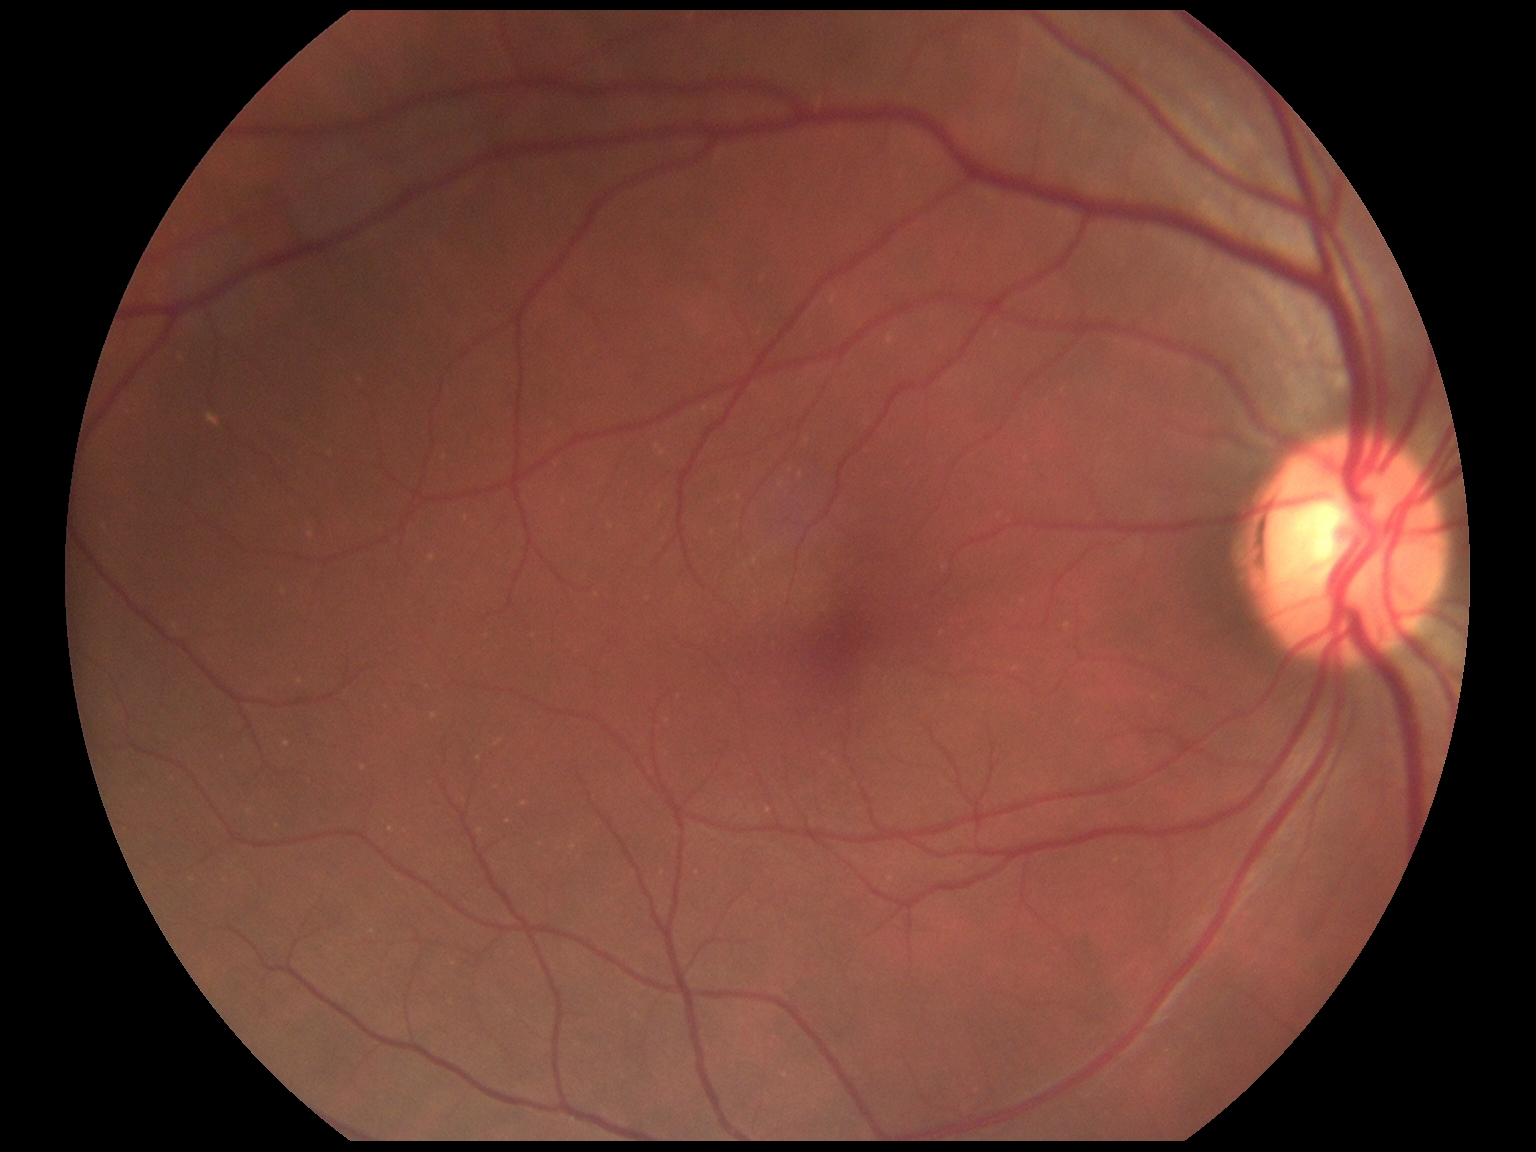

No DR findings. Retinopathy grade is 0 — no visible signs of diabetic retinopathy.